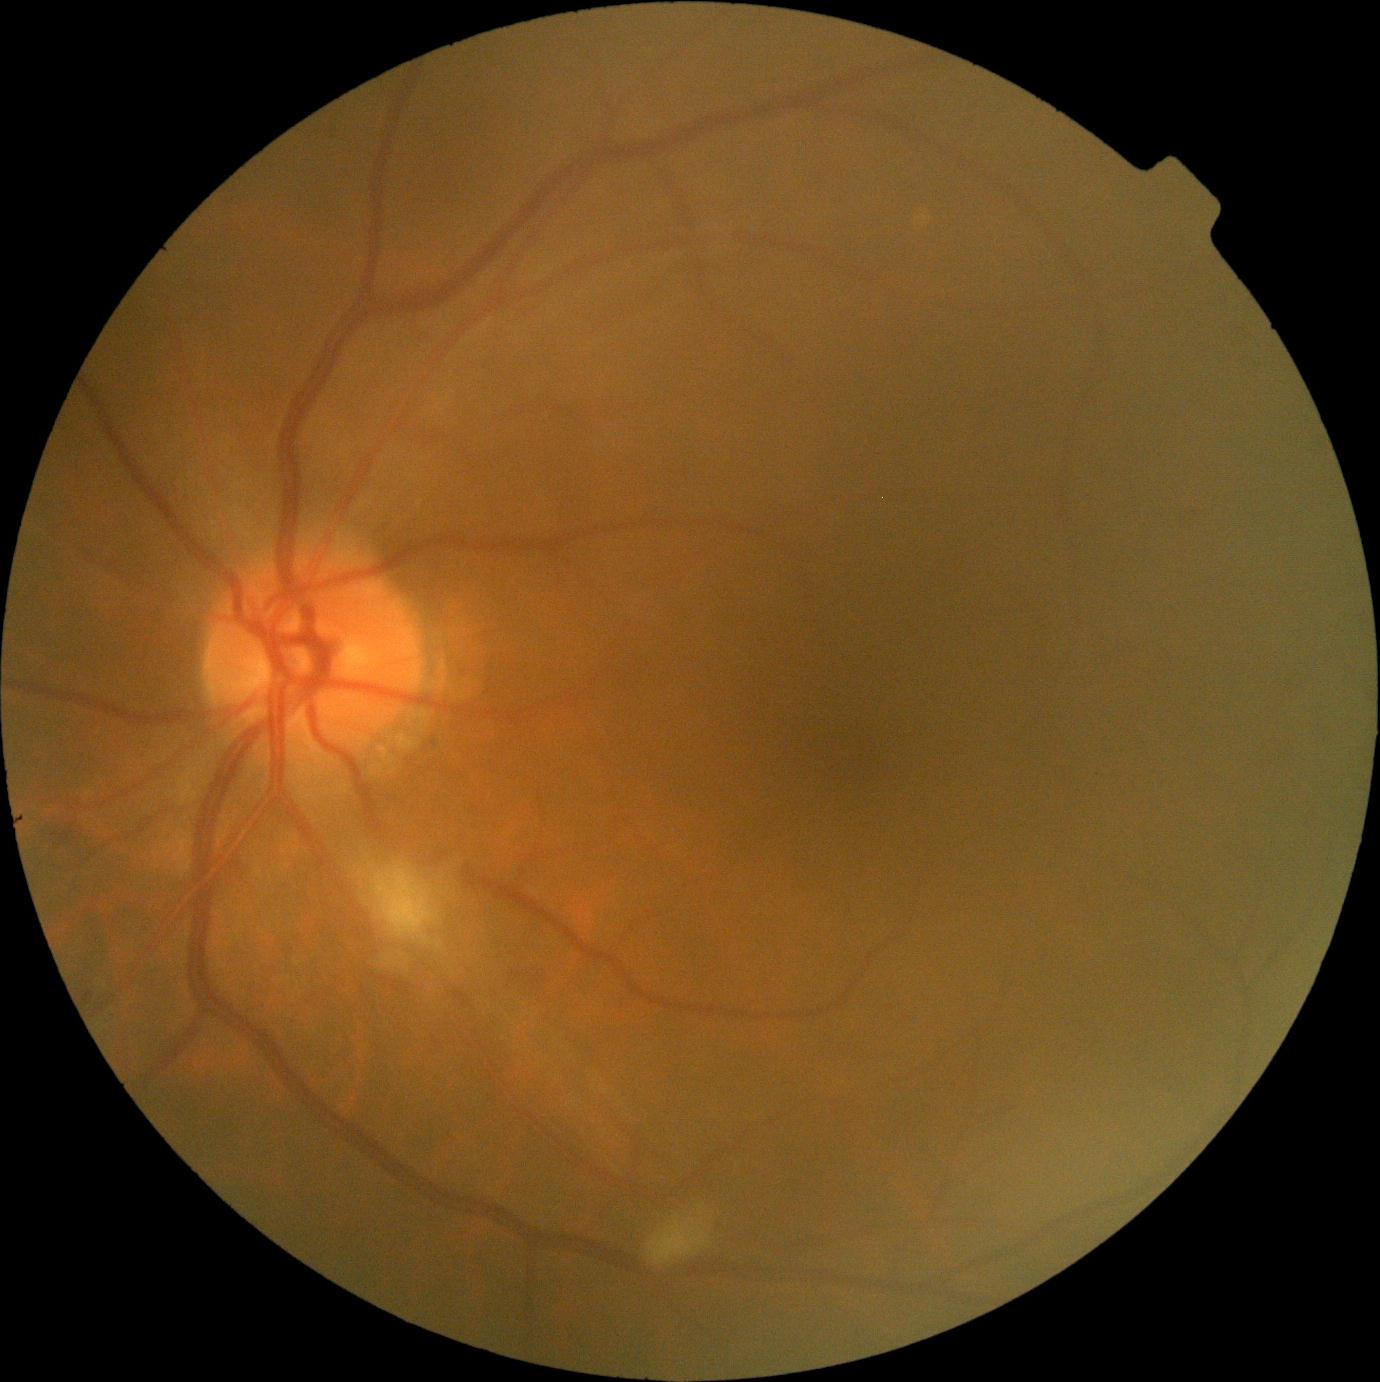 DR class = non-proliferative diabetic retinopathy, diabetic retinopathy severity = grade 2 (moderate NPDR).